2352x1568.
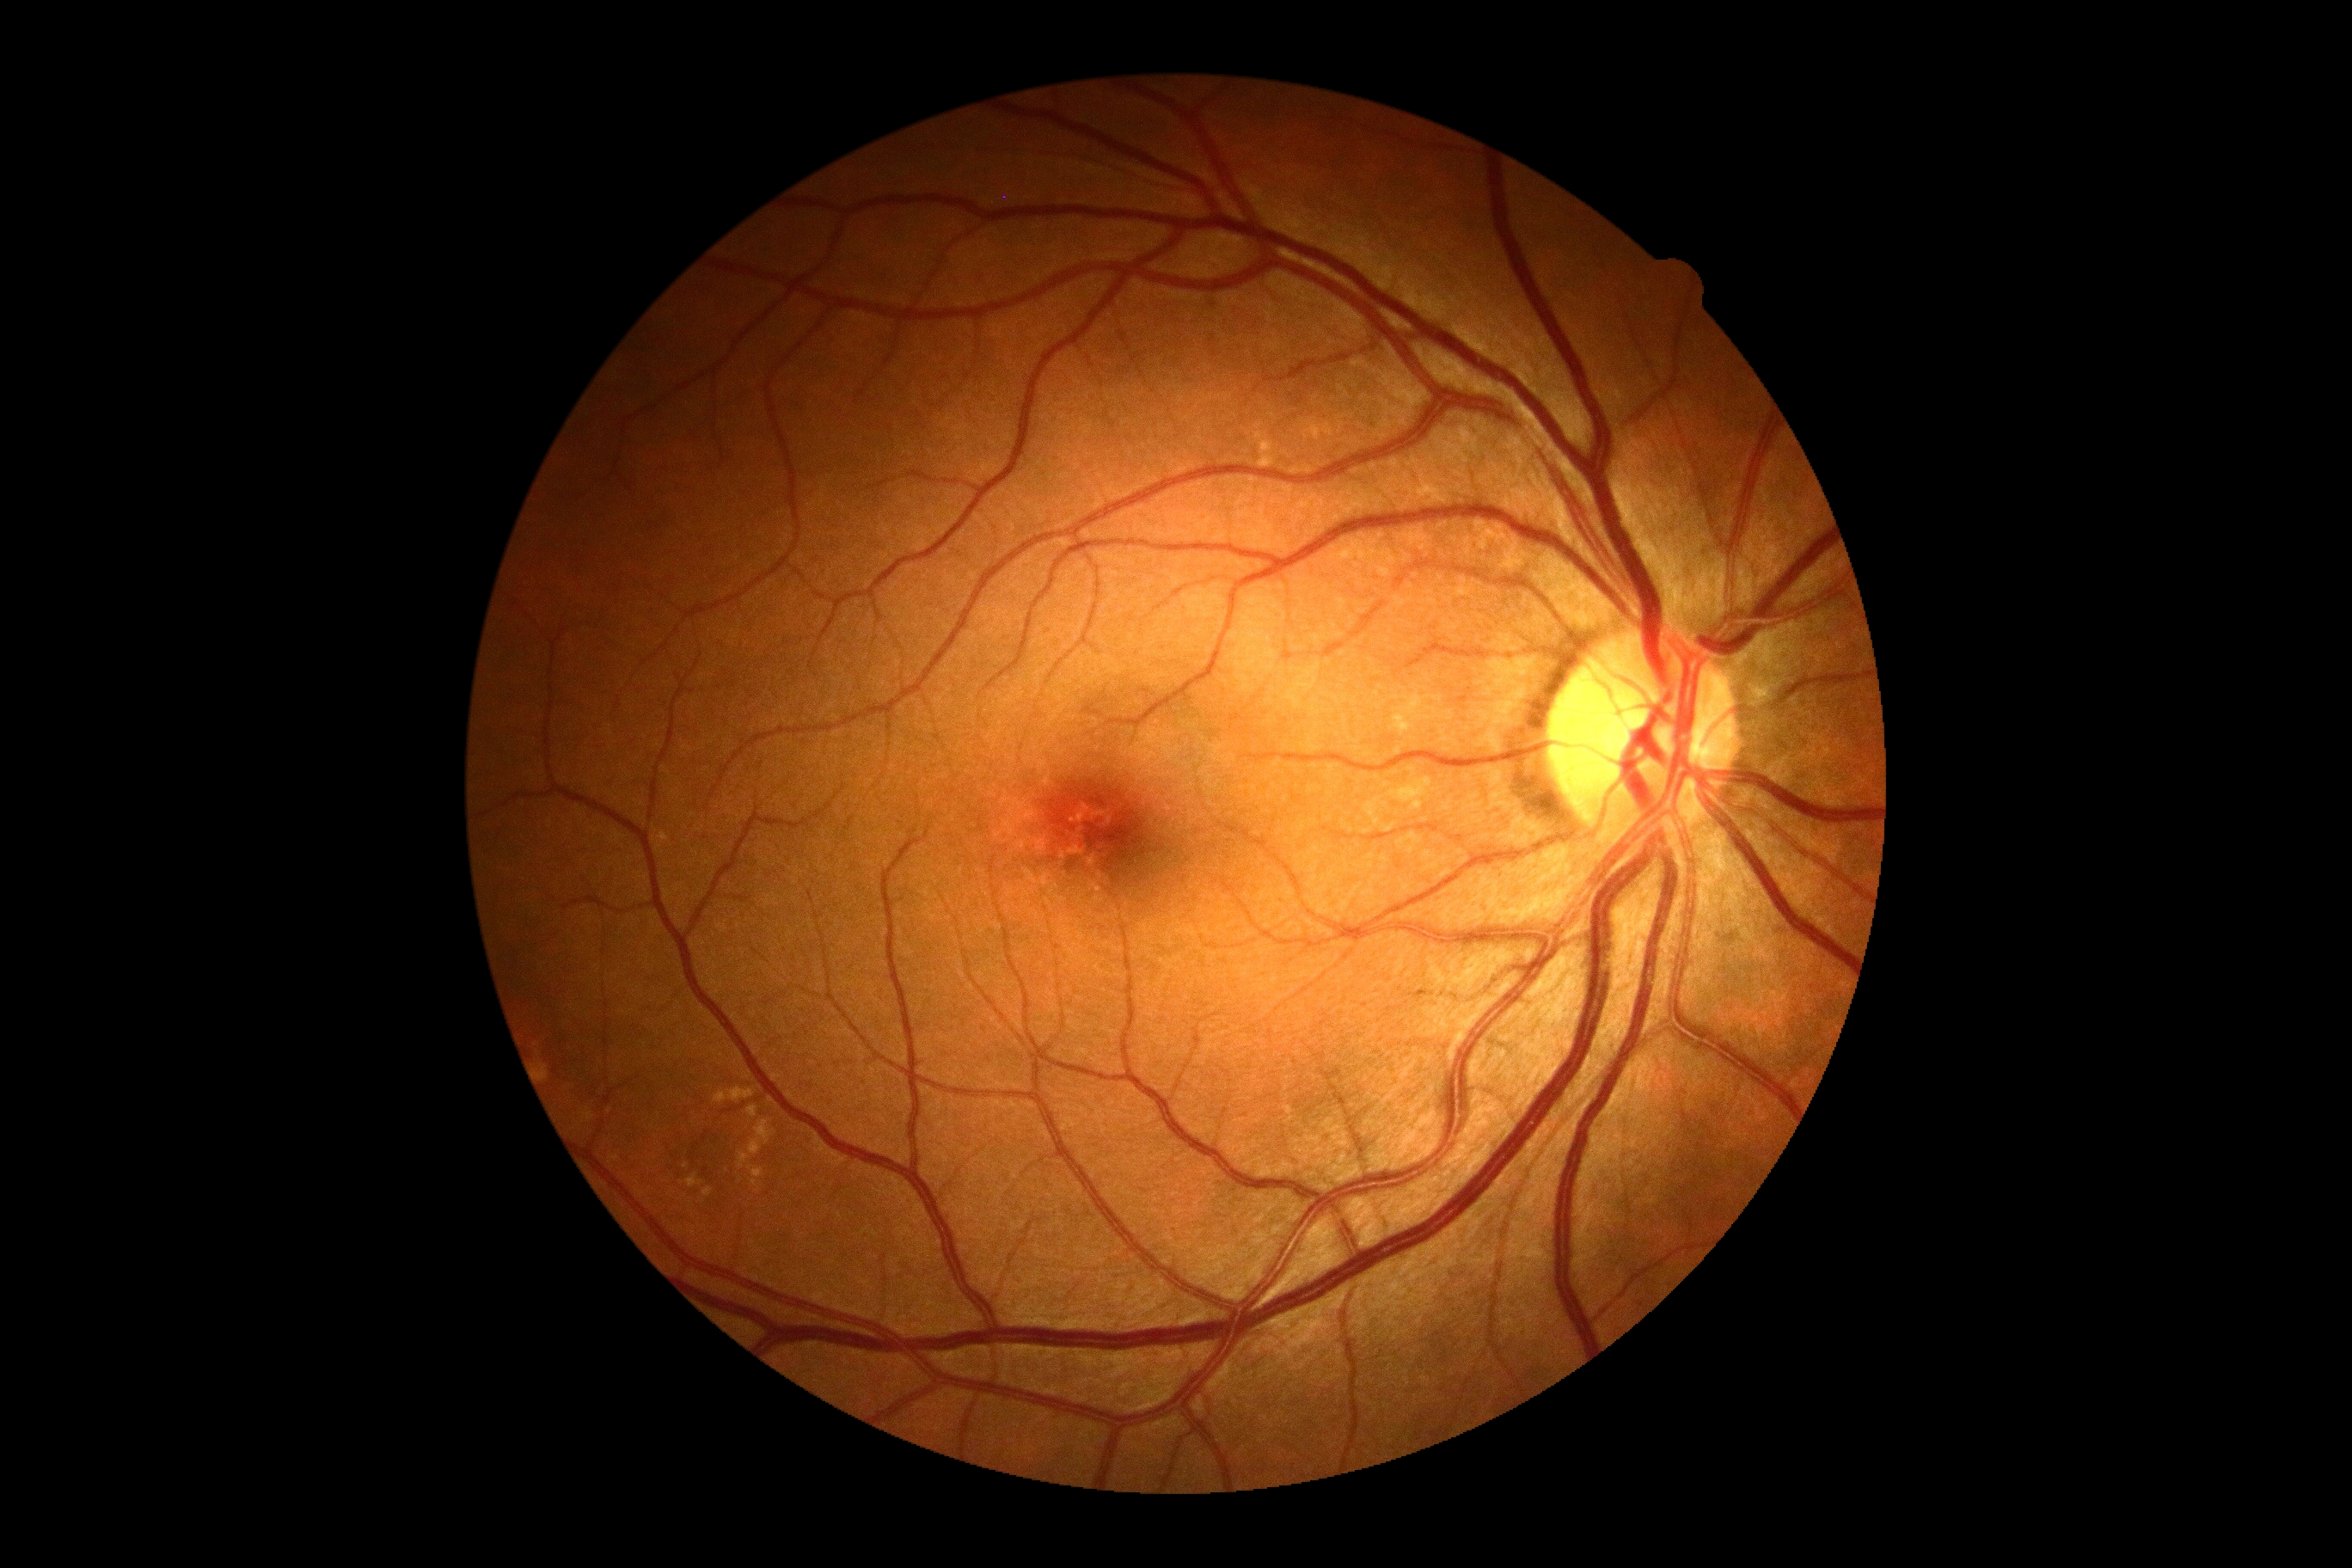

DR grade is 0.